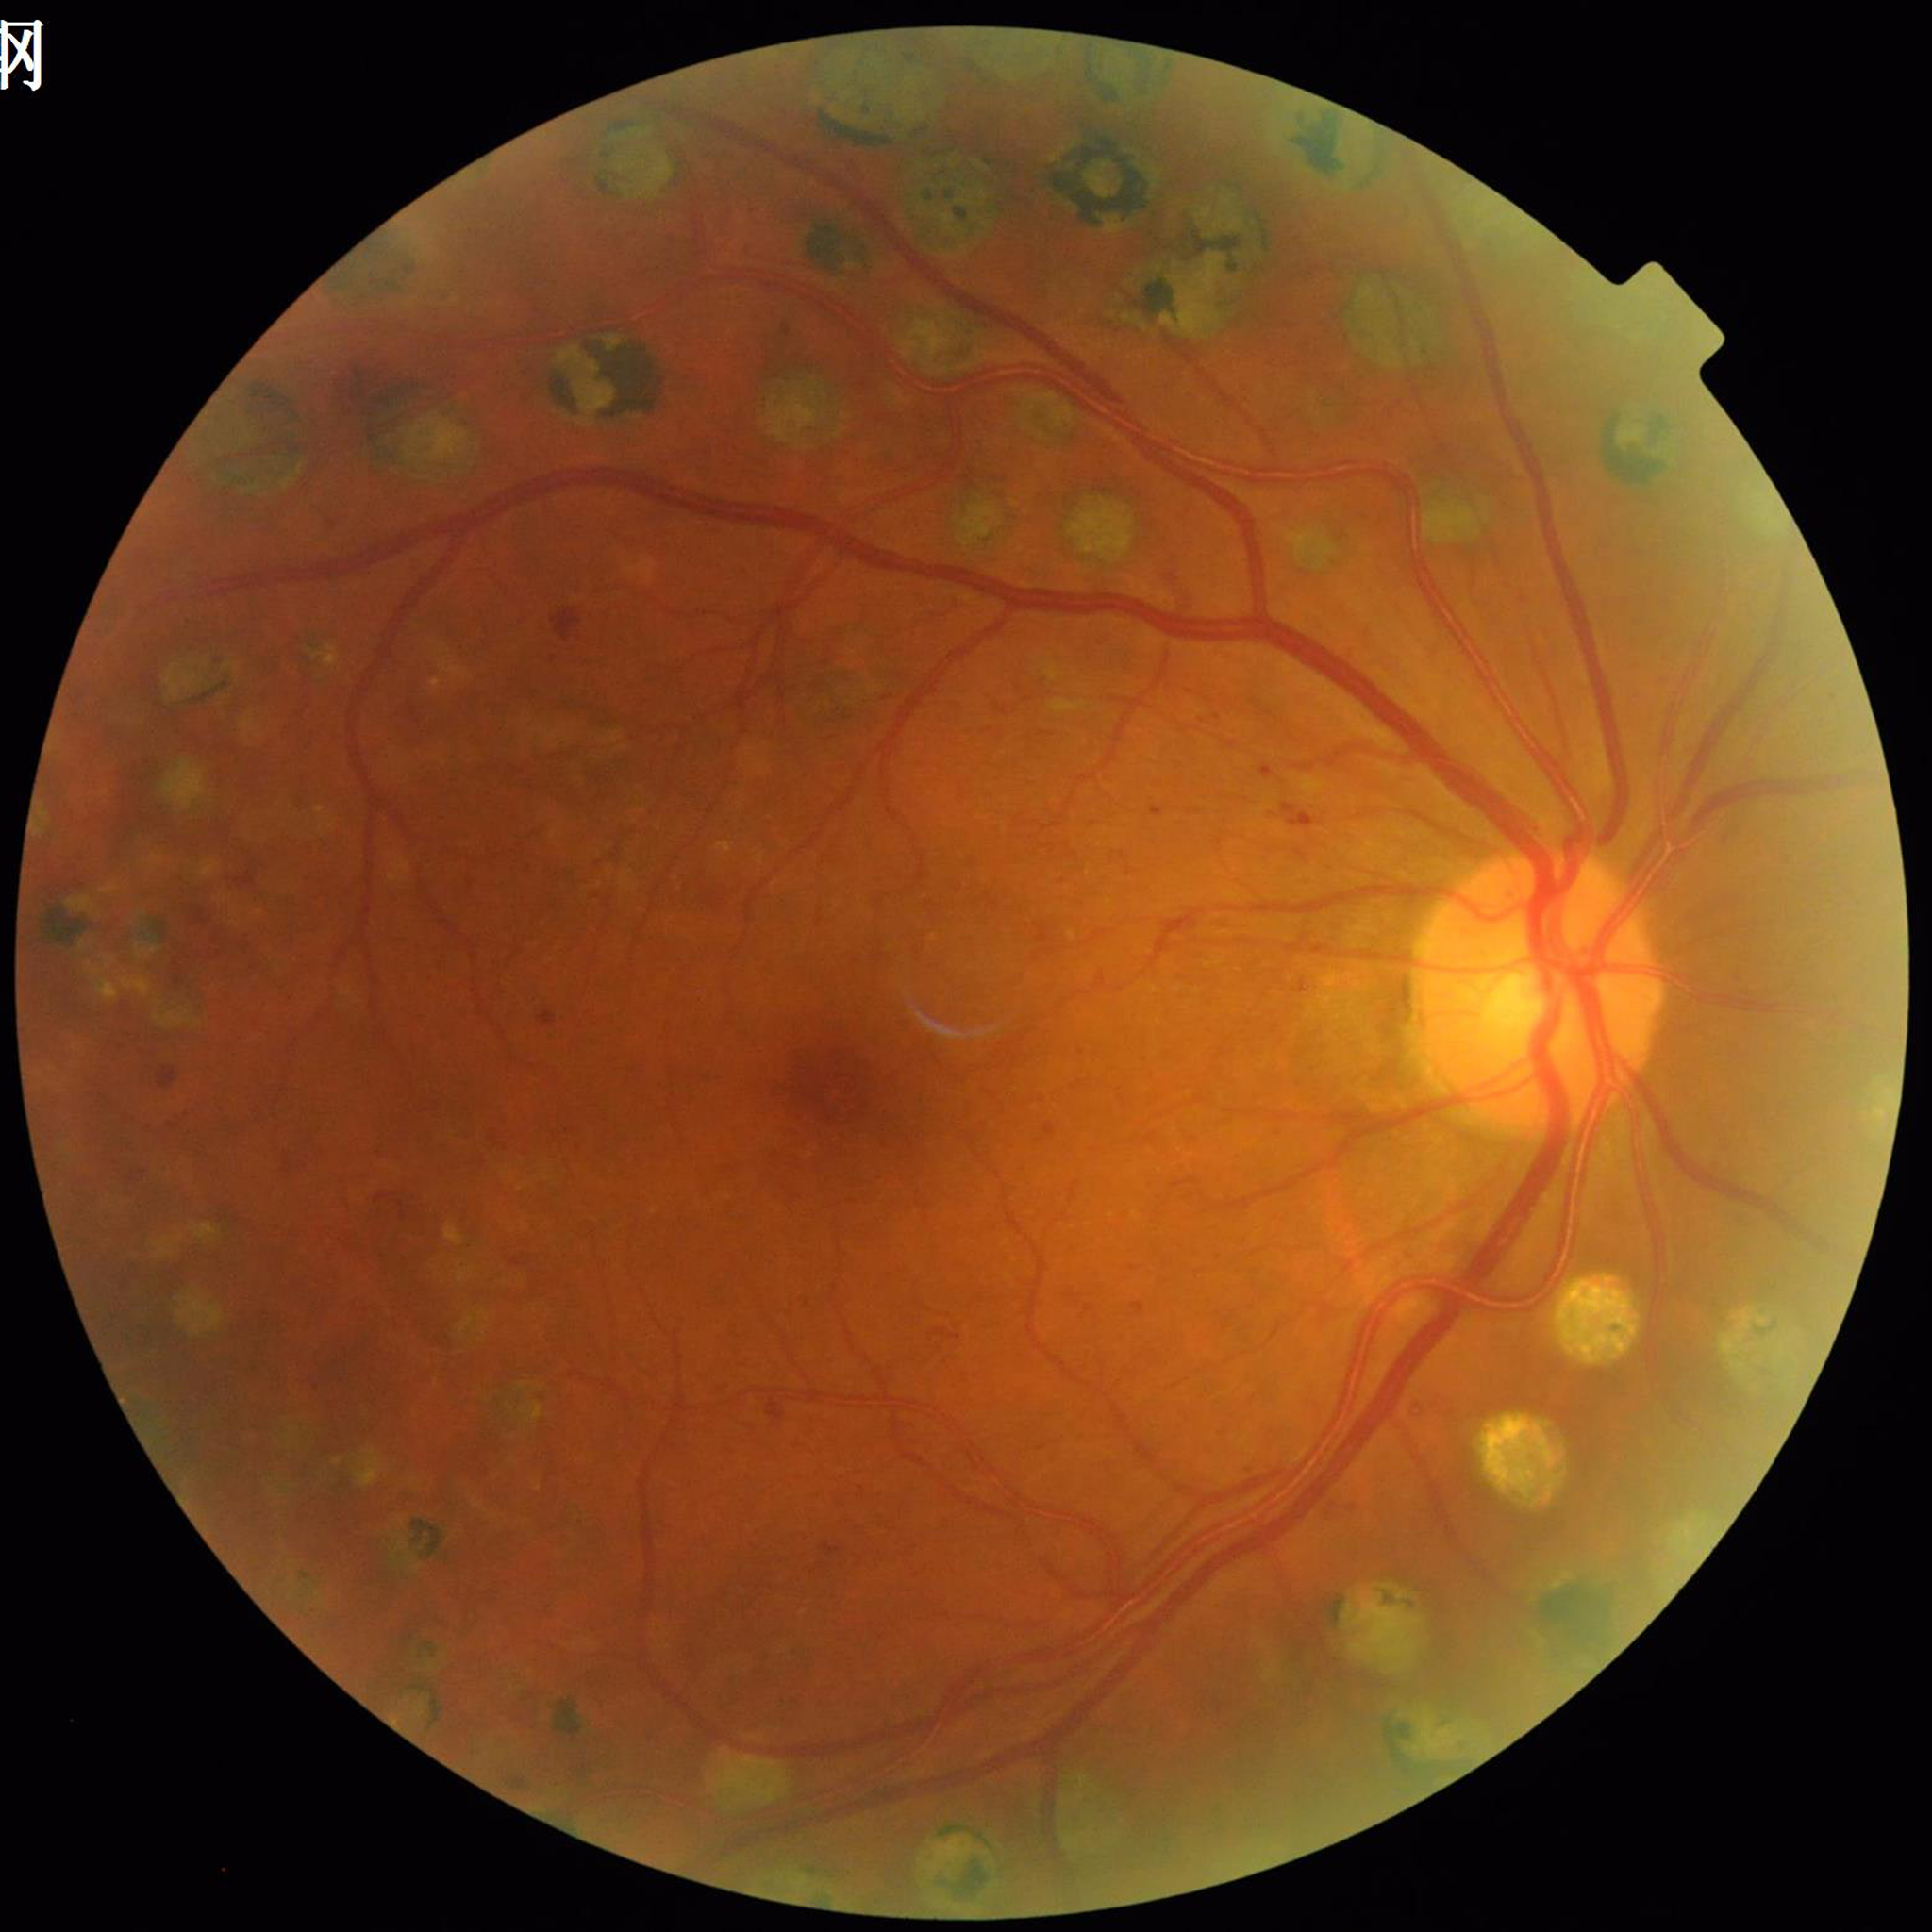 Quality assessment: adequate. The patient was diagnosed with diabetic retinopathy.